848 by 848 pixels · fundus photo · without pupil dilation — 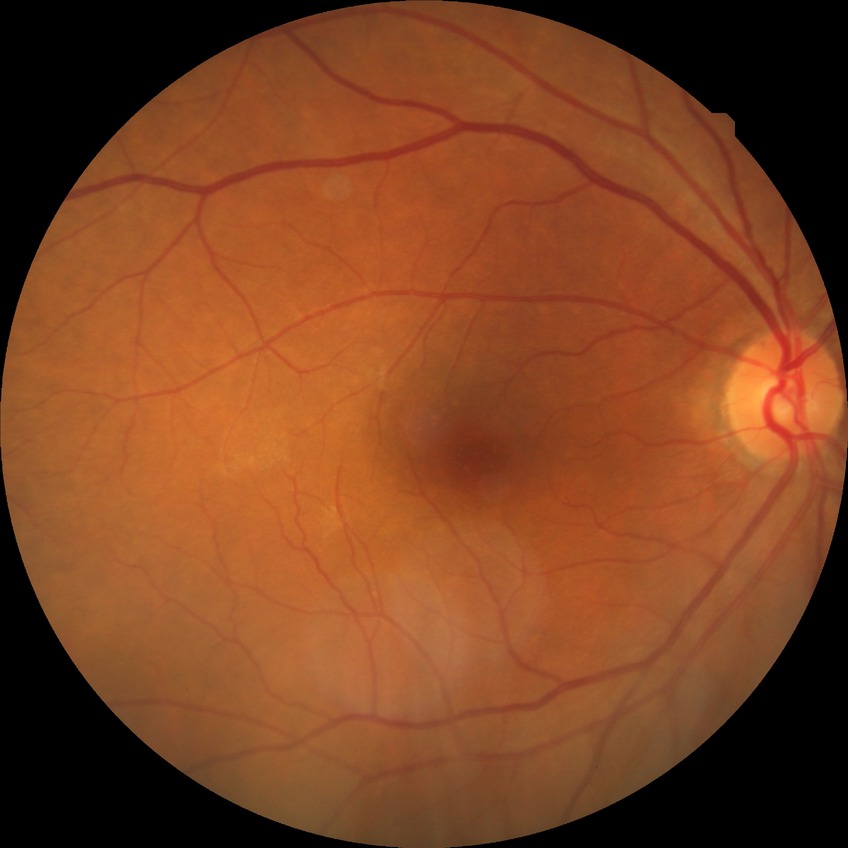

DR: NDR.